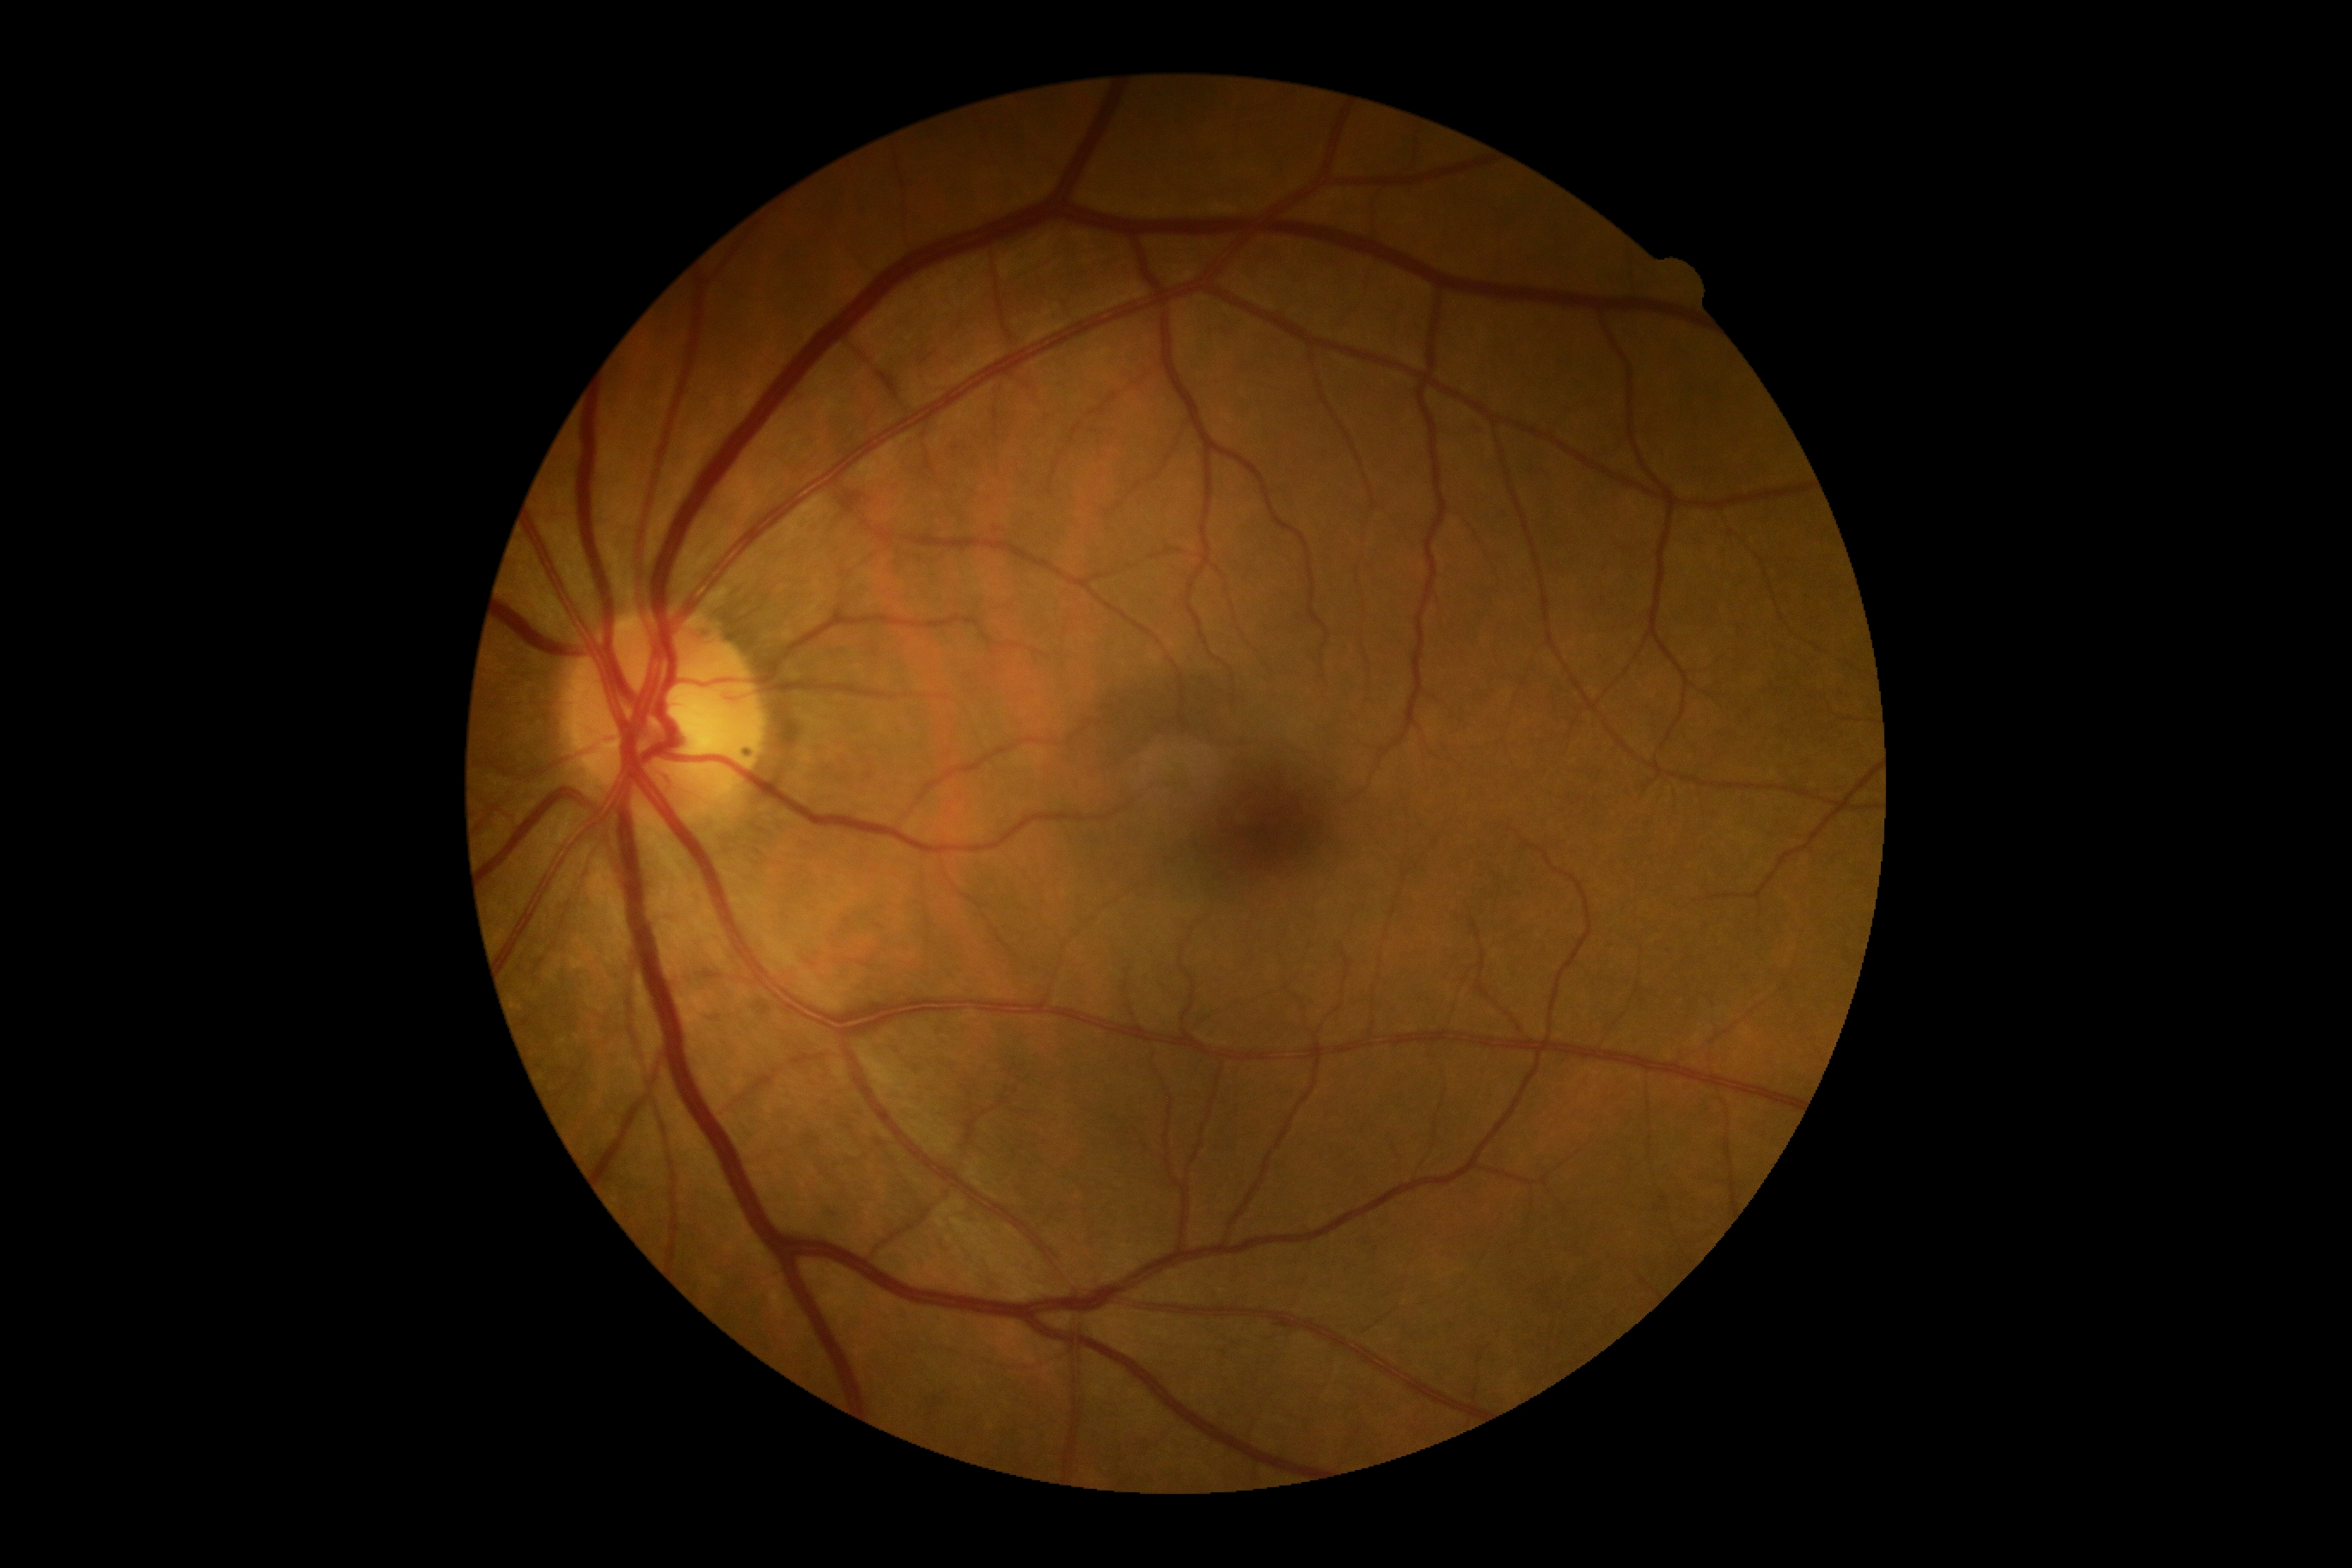

DR grade is no apparent retinopathy (0).